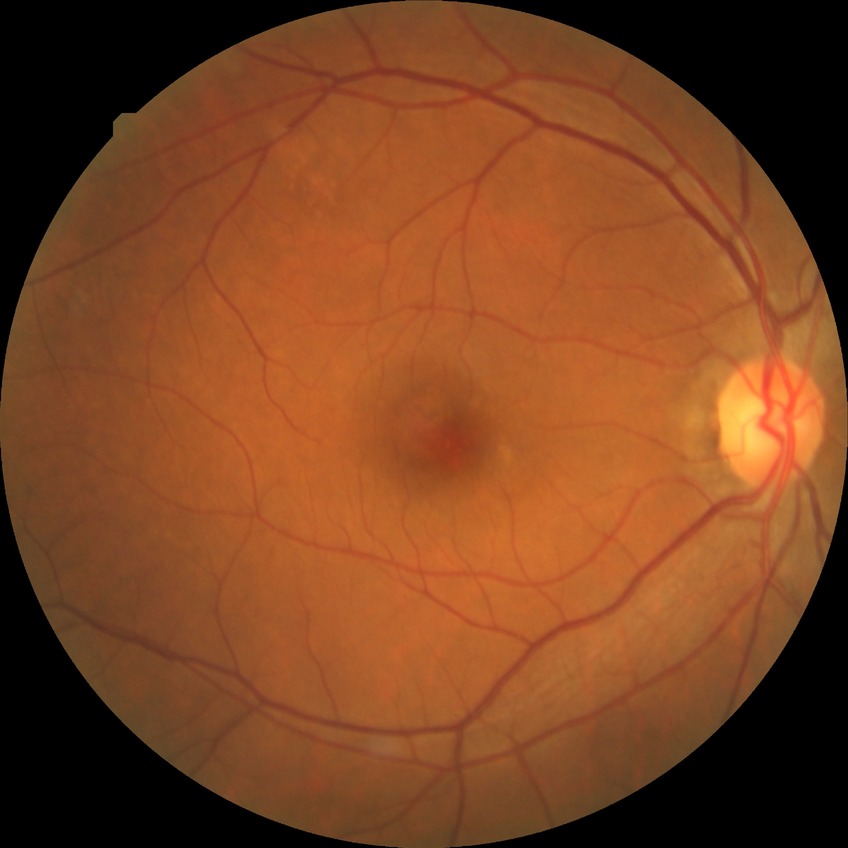
diabetic retinopathy (DR): NDR (no diabetic retinopathy)